45° field of view · retinal fundus photograph · 2352 x 1568 pixels: 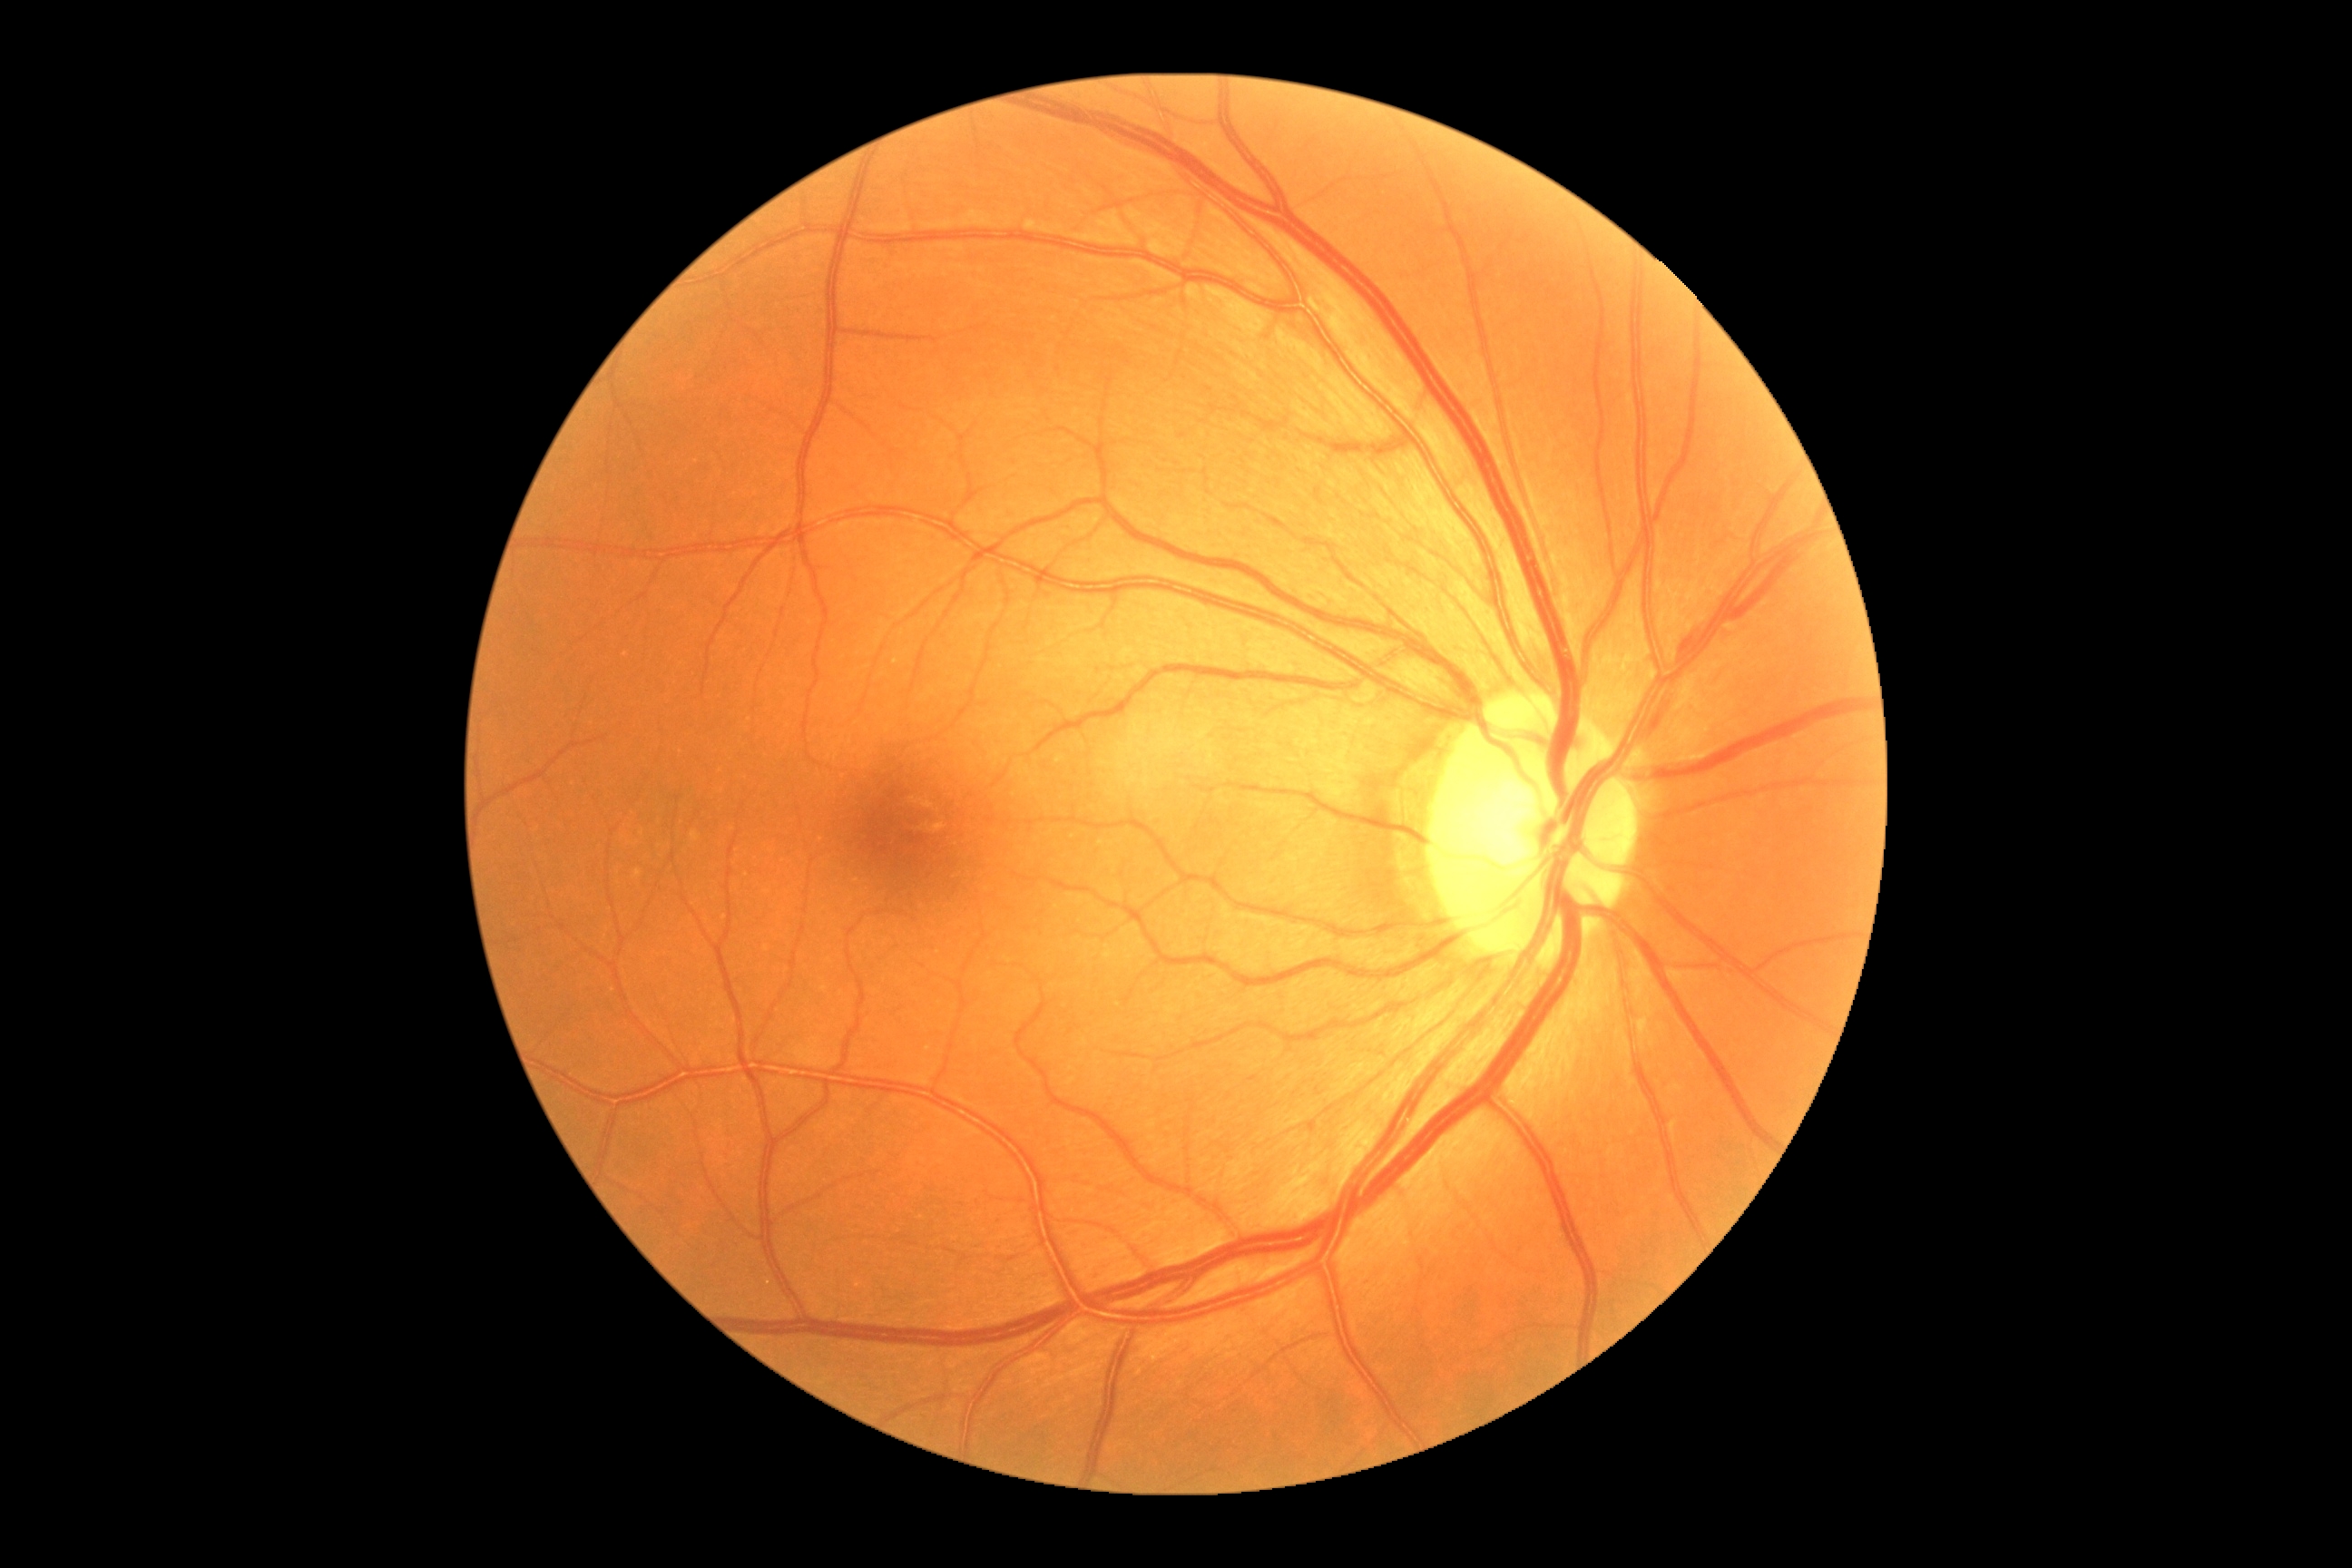

Diabetic retinopathy severity is no apparent diabetic retinopathy (grade 0).